Infant wide-field fundus photograph. Camera: Phoenix ICON (100° FOV). 1240x1240
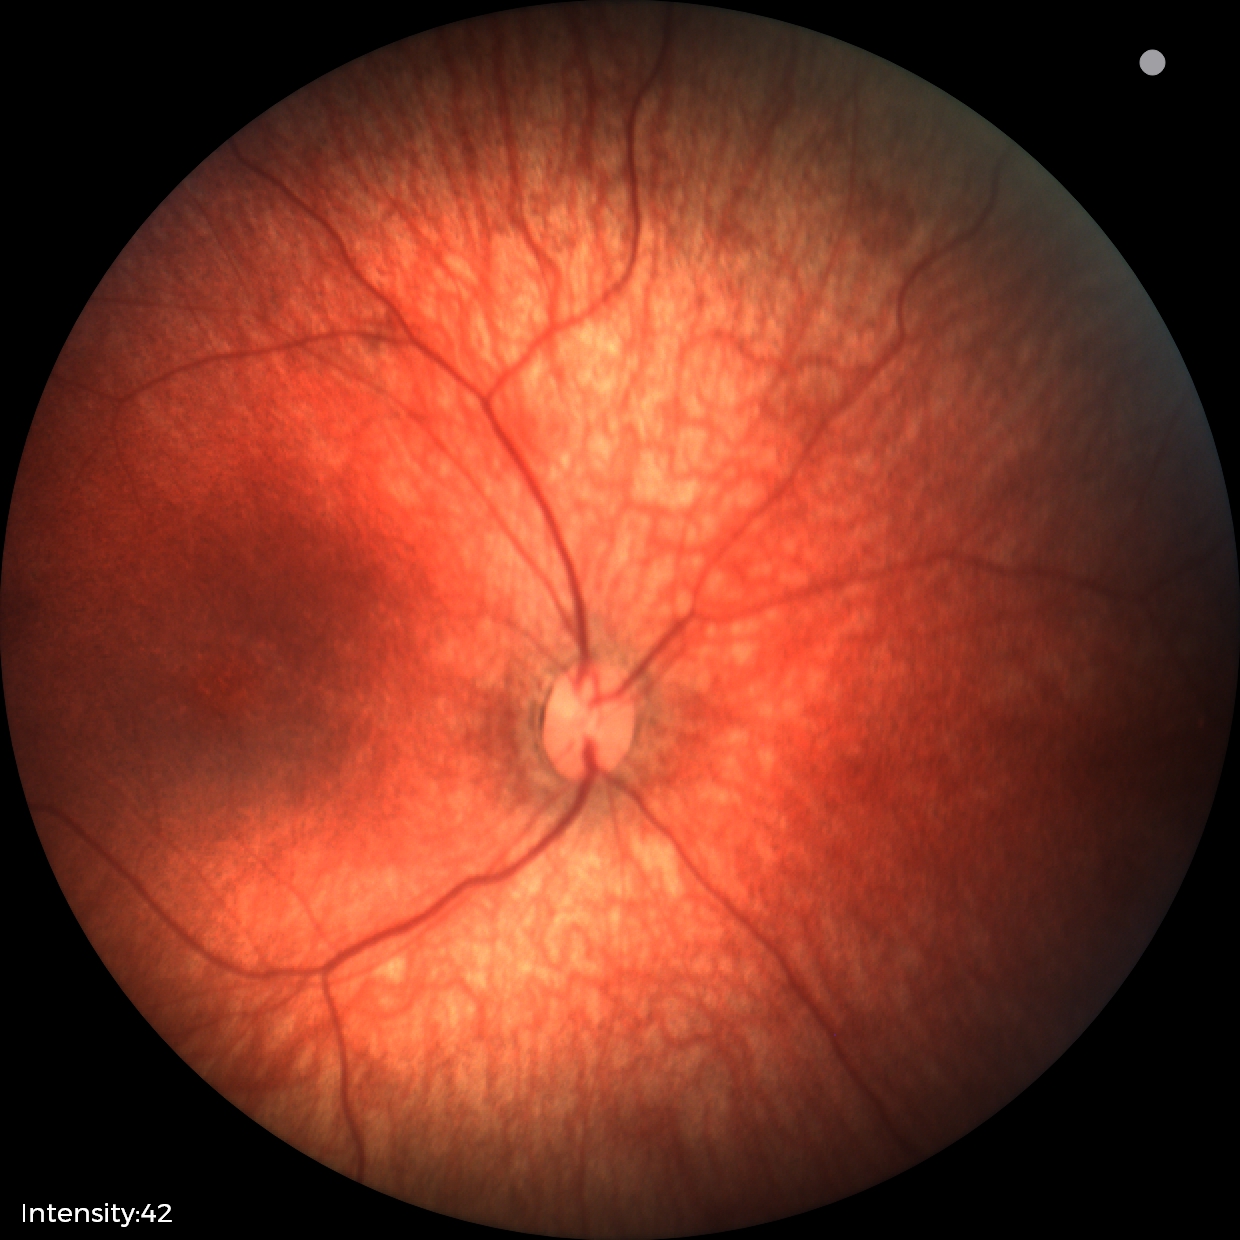

No retinal pathology identified on screening.